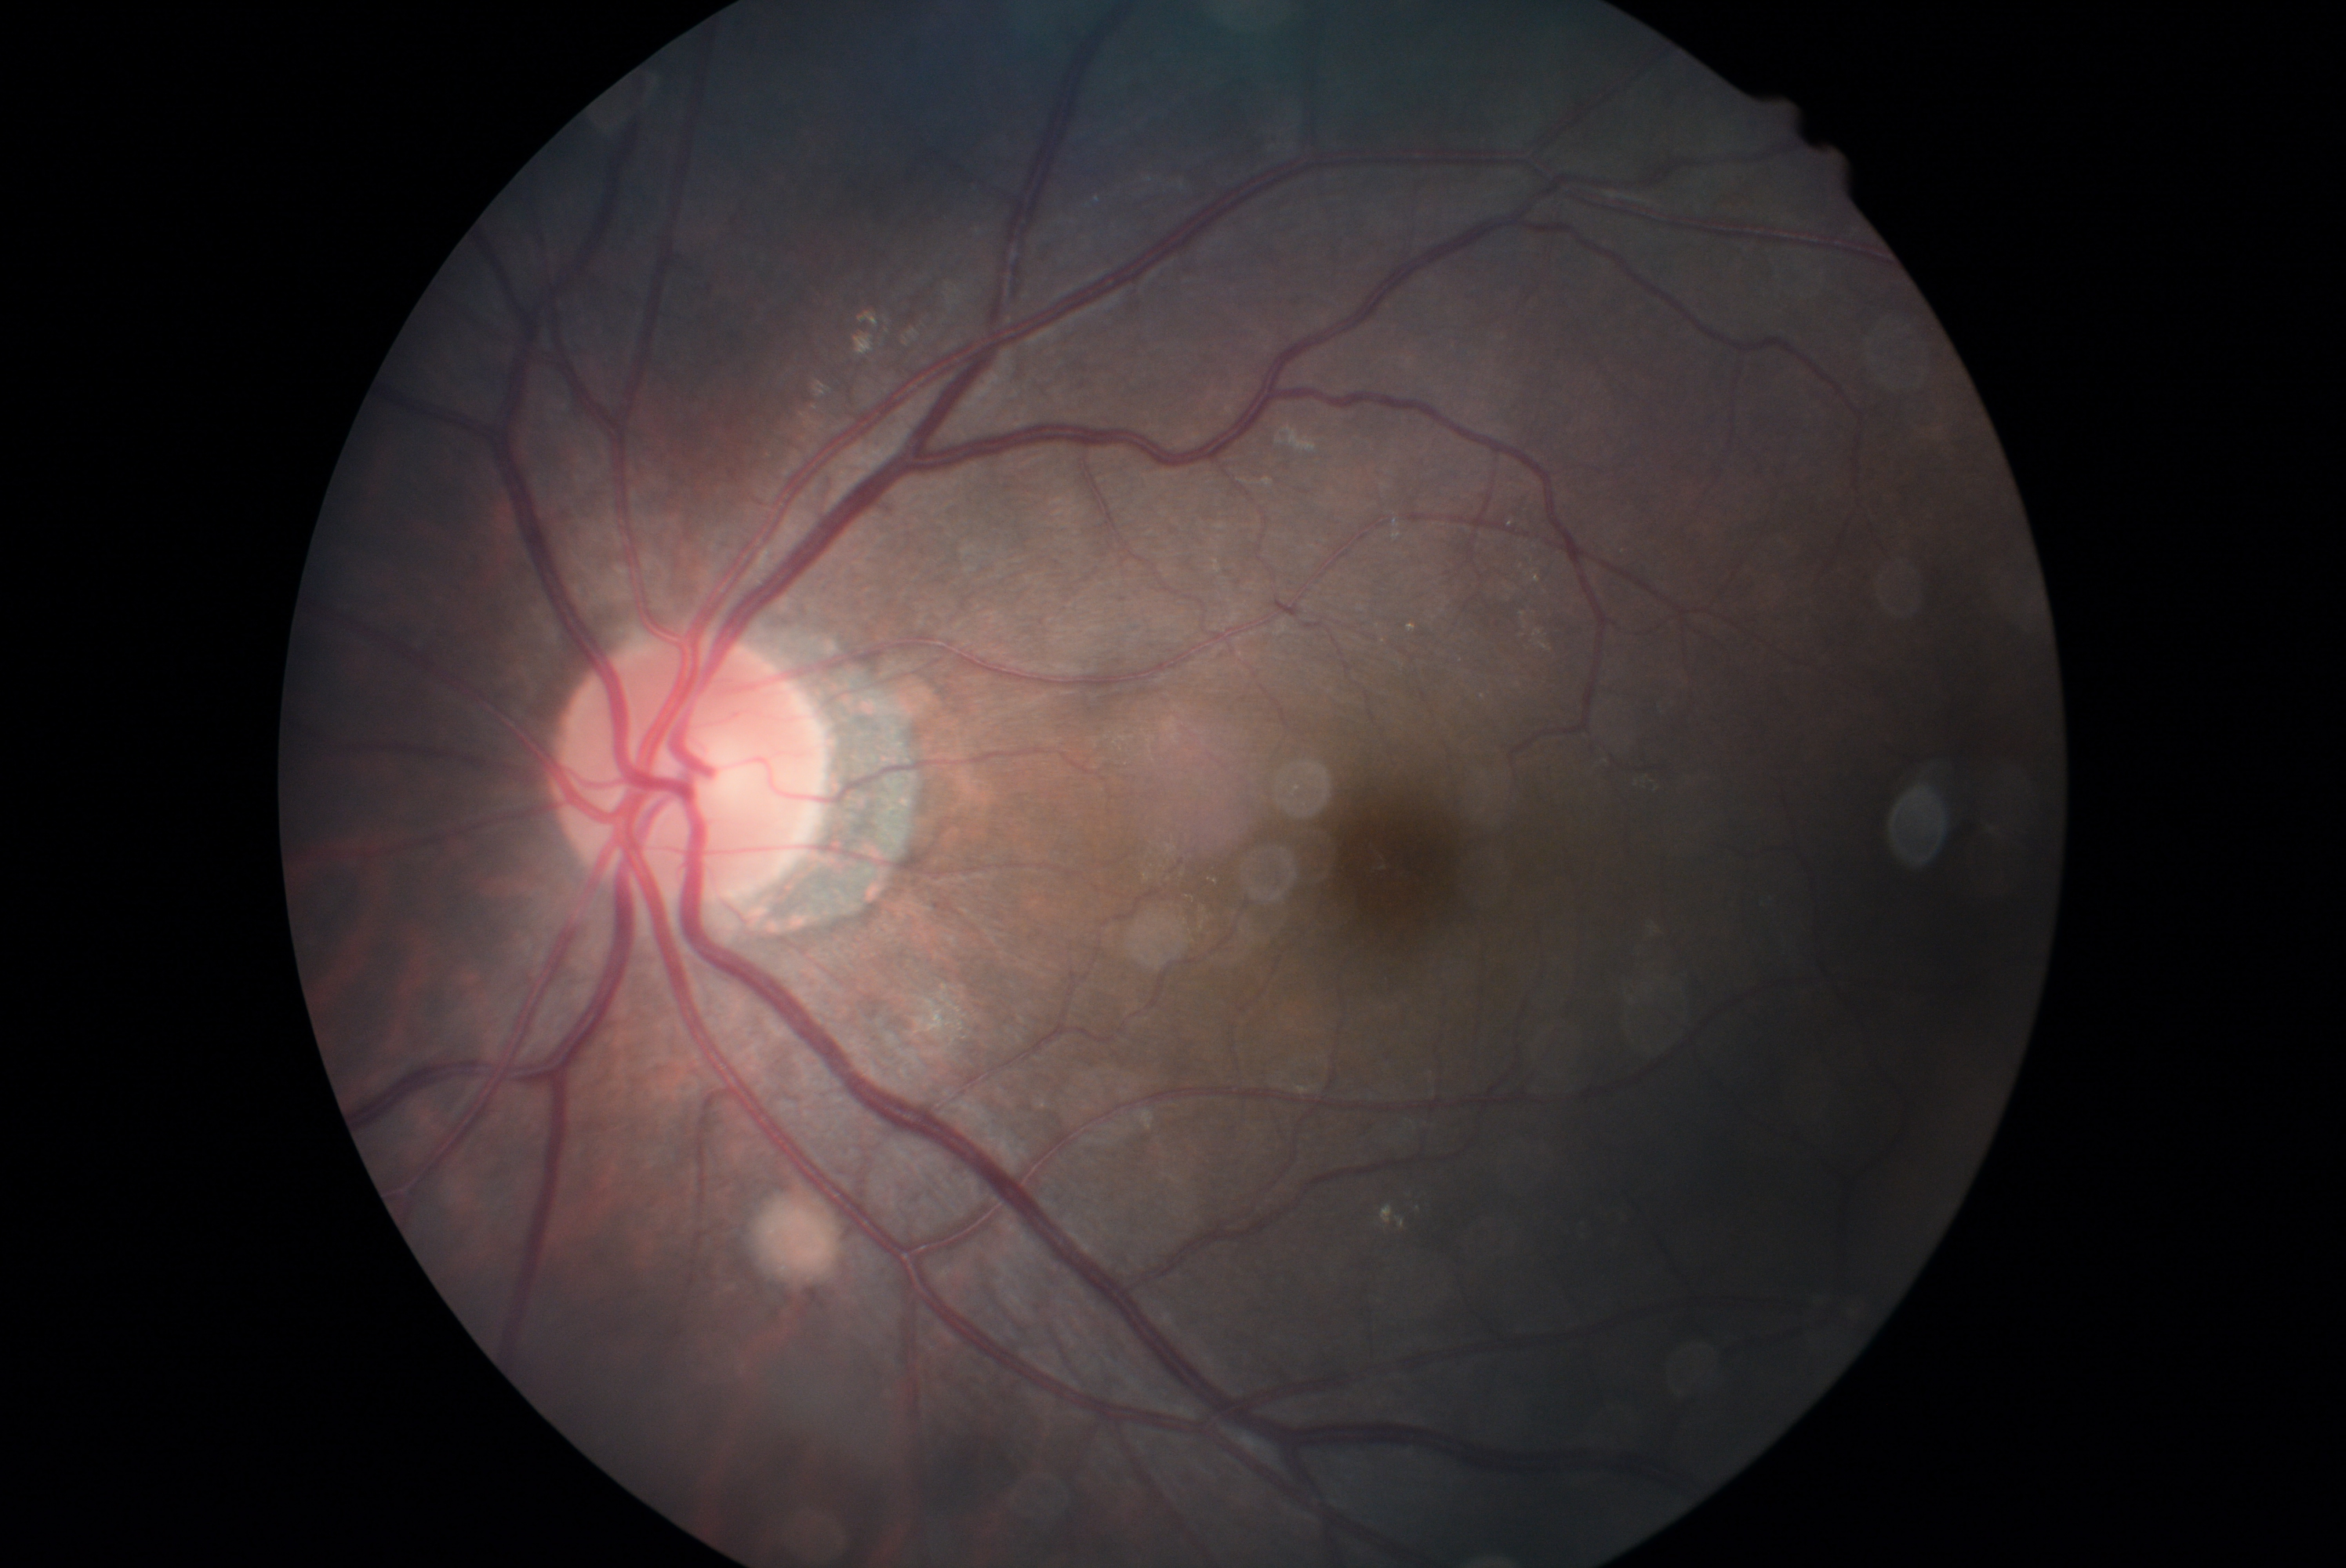
DR is grade 2.